Color fundus image: 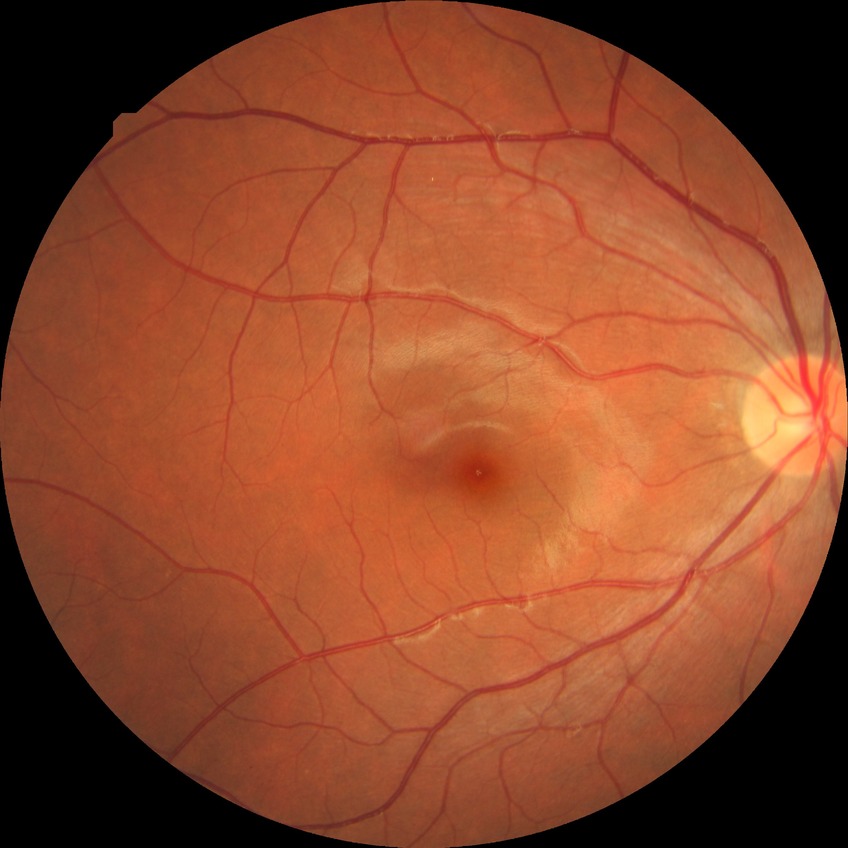   davis_grade: NDR (no diabetic retinopathy)